45-degree field of view — 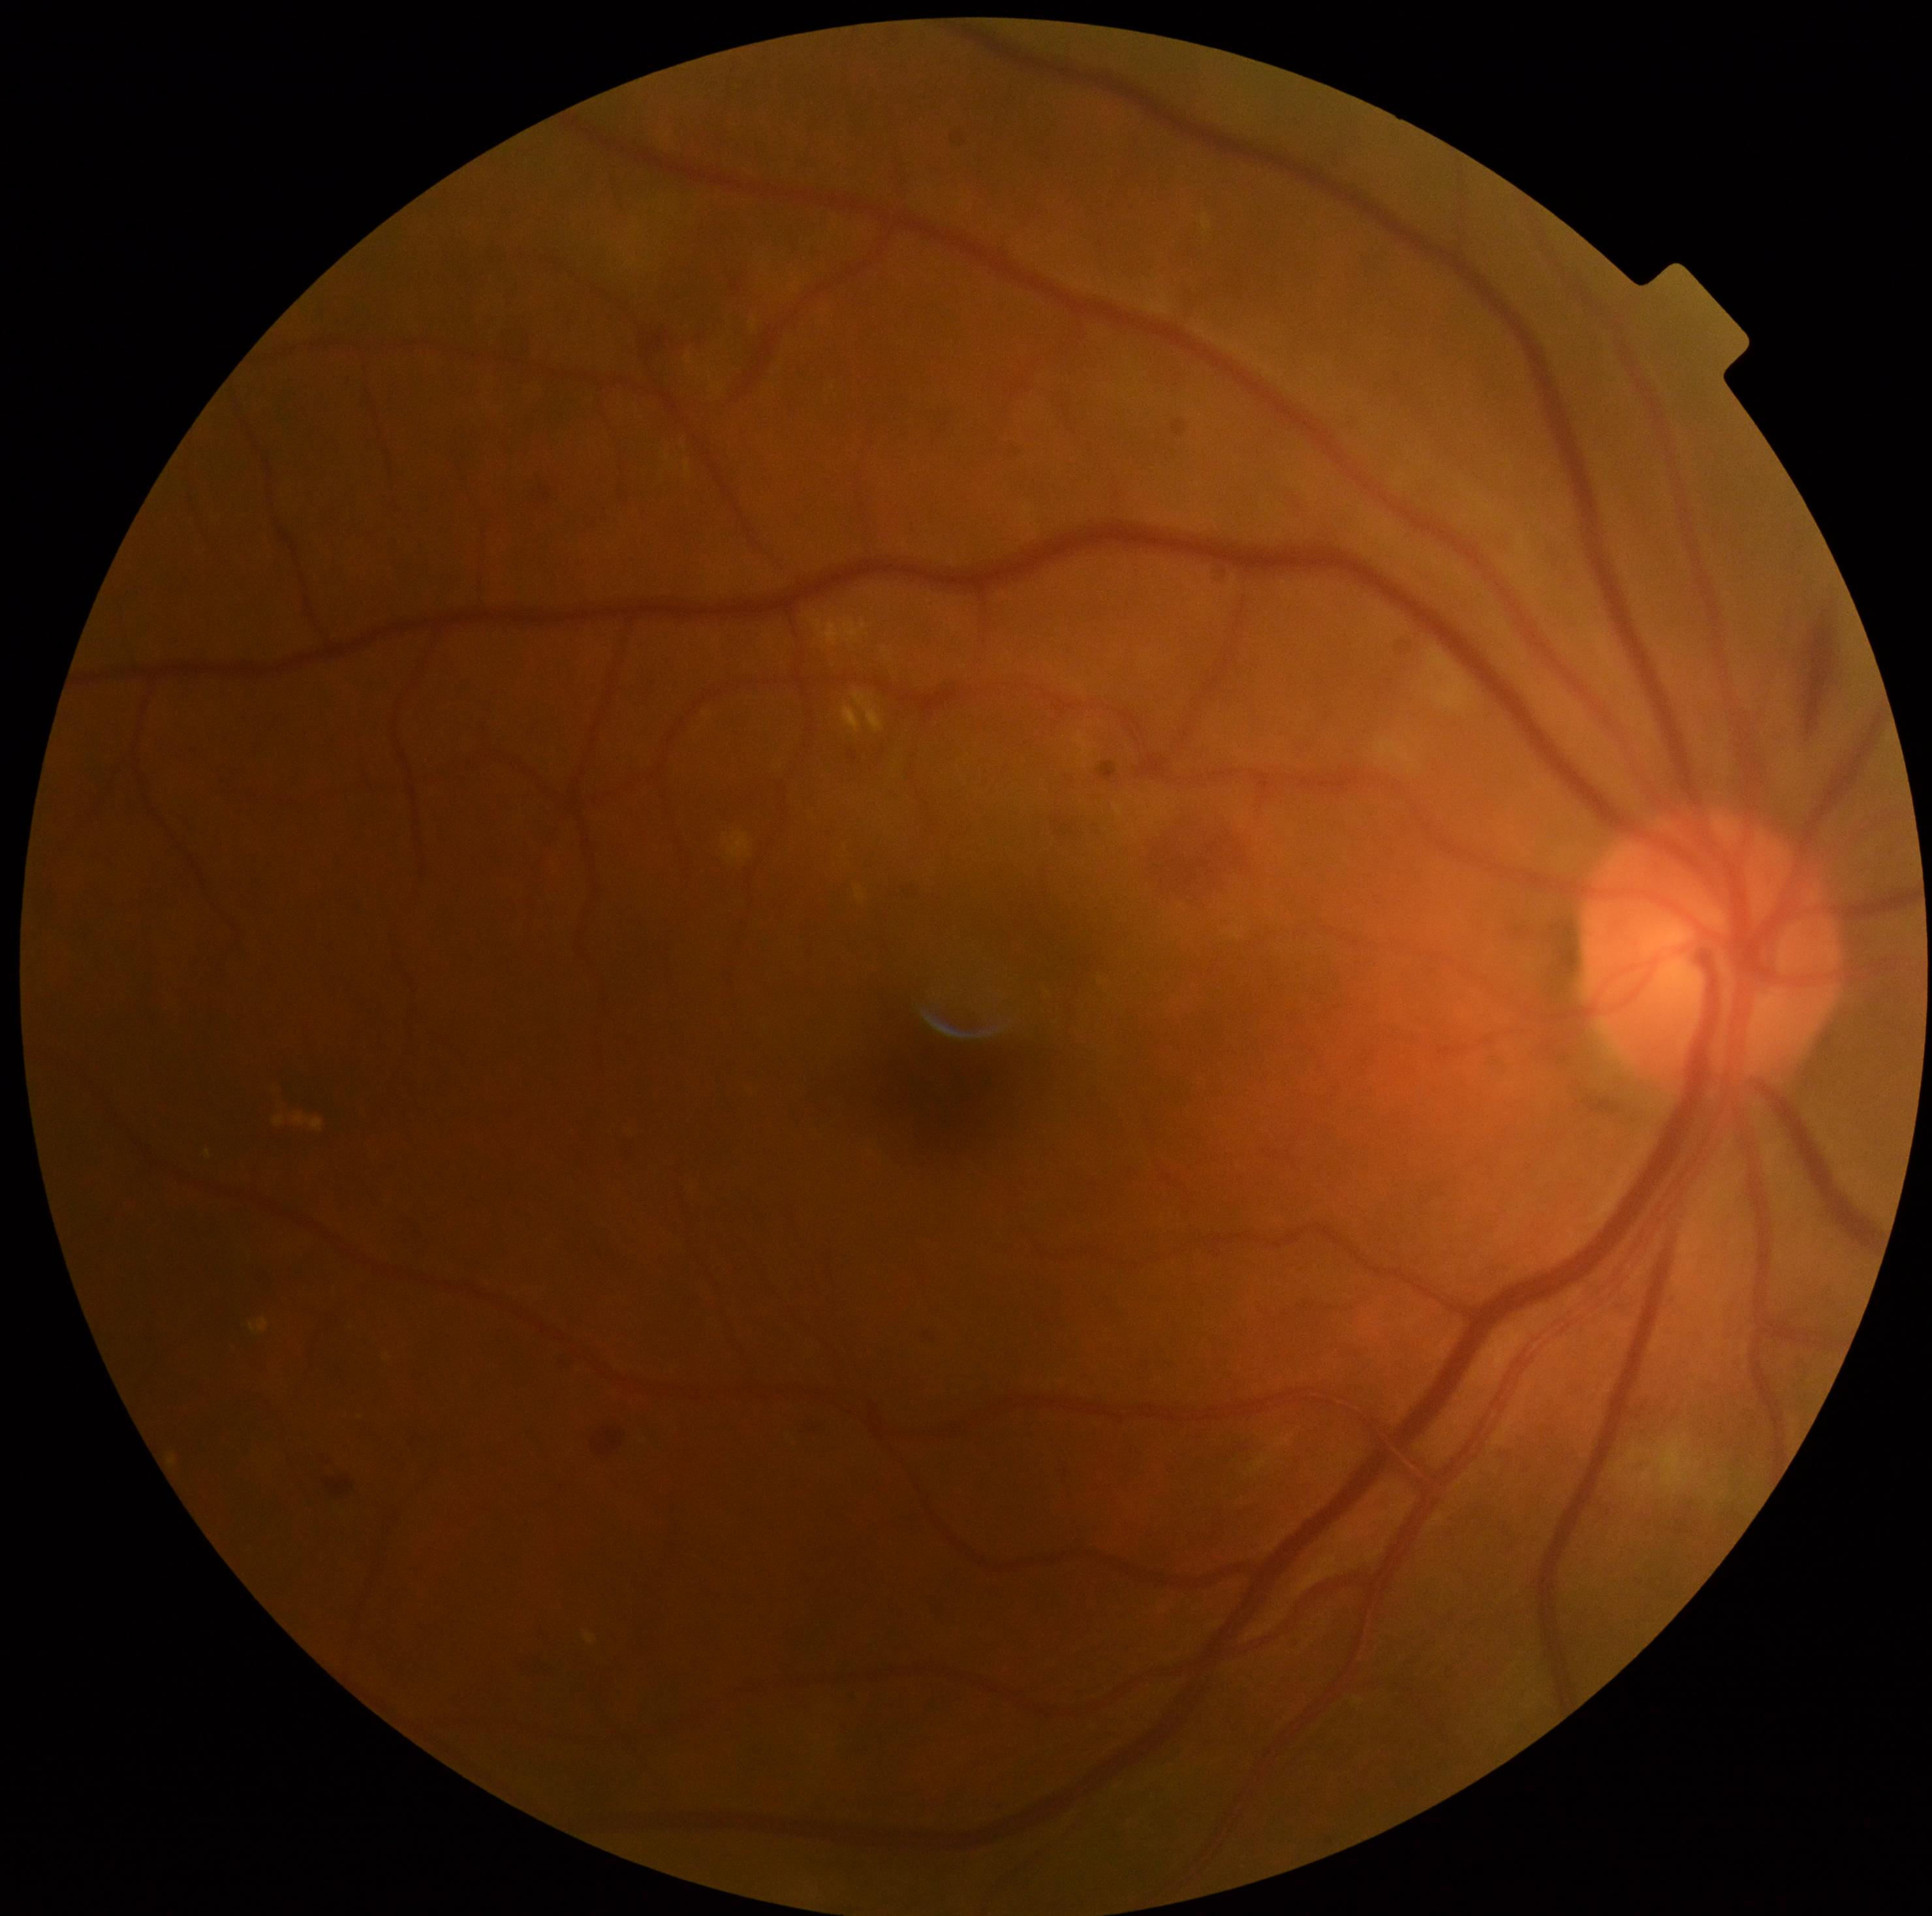
diabetic retinopathy (DR)@2/4.